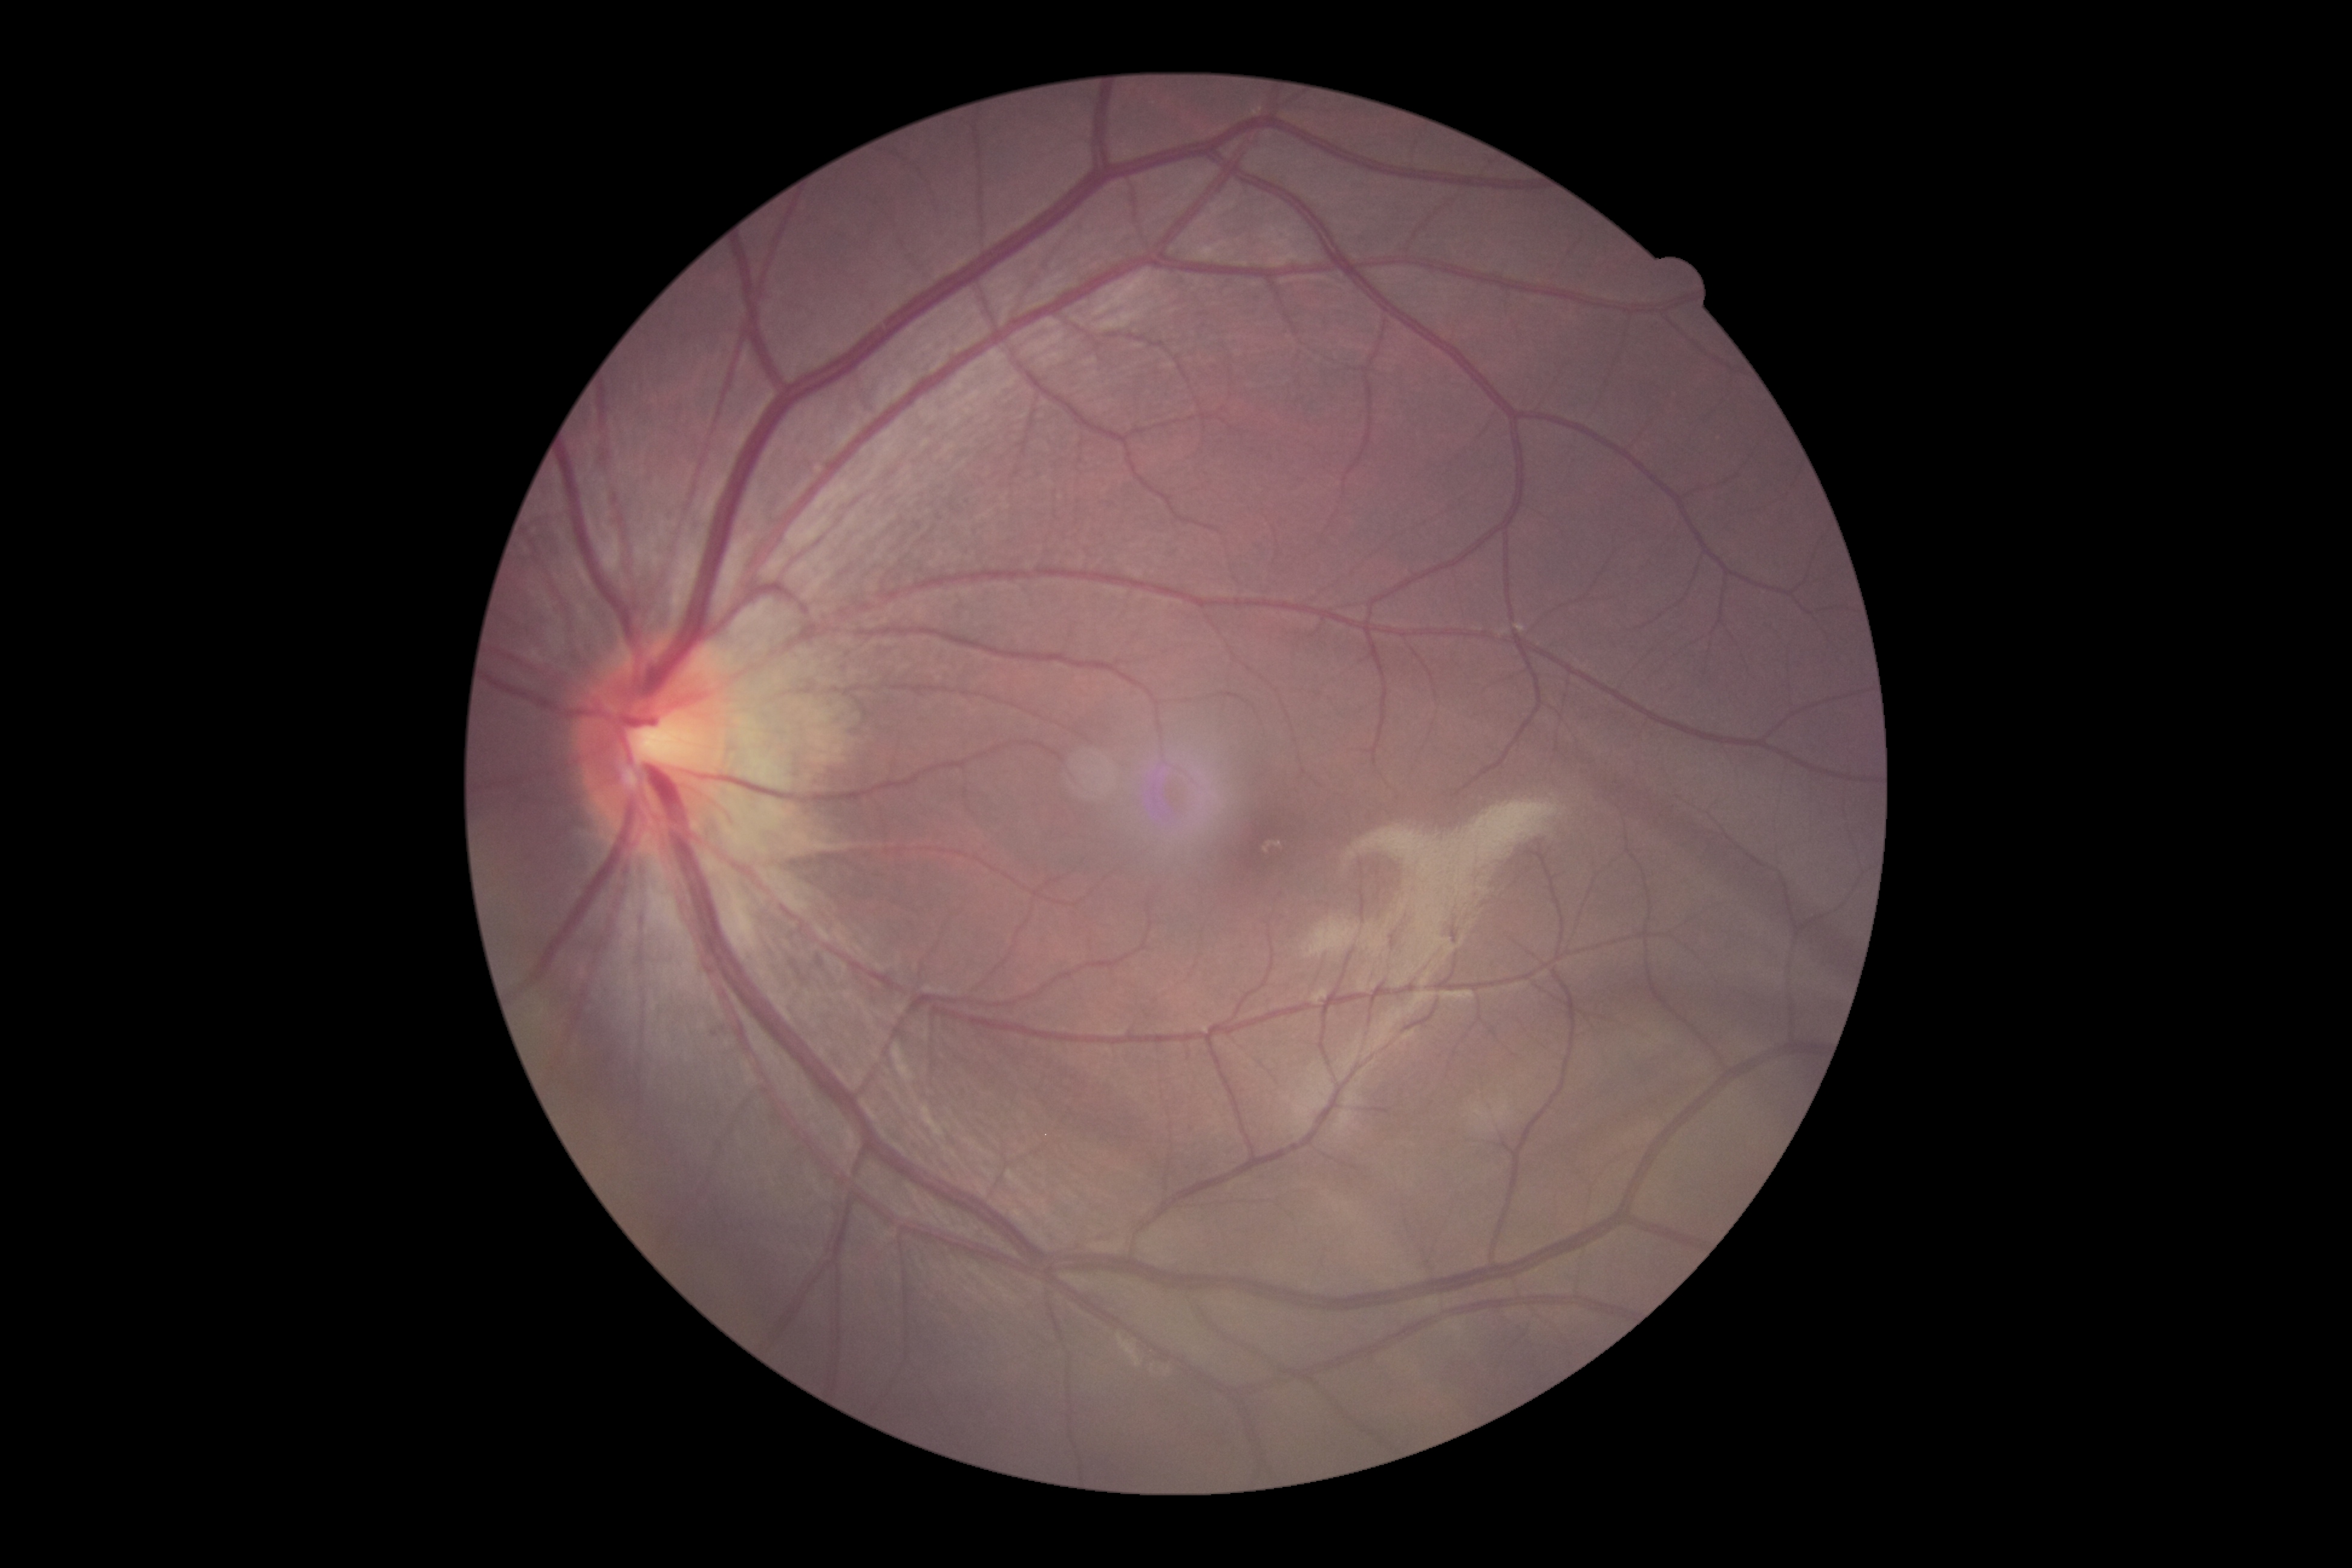

DR: grade 0 (no apparent retinopathy).